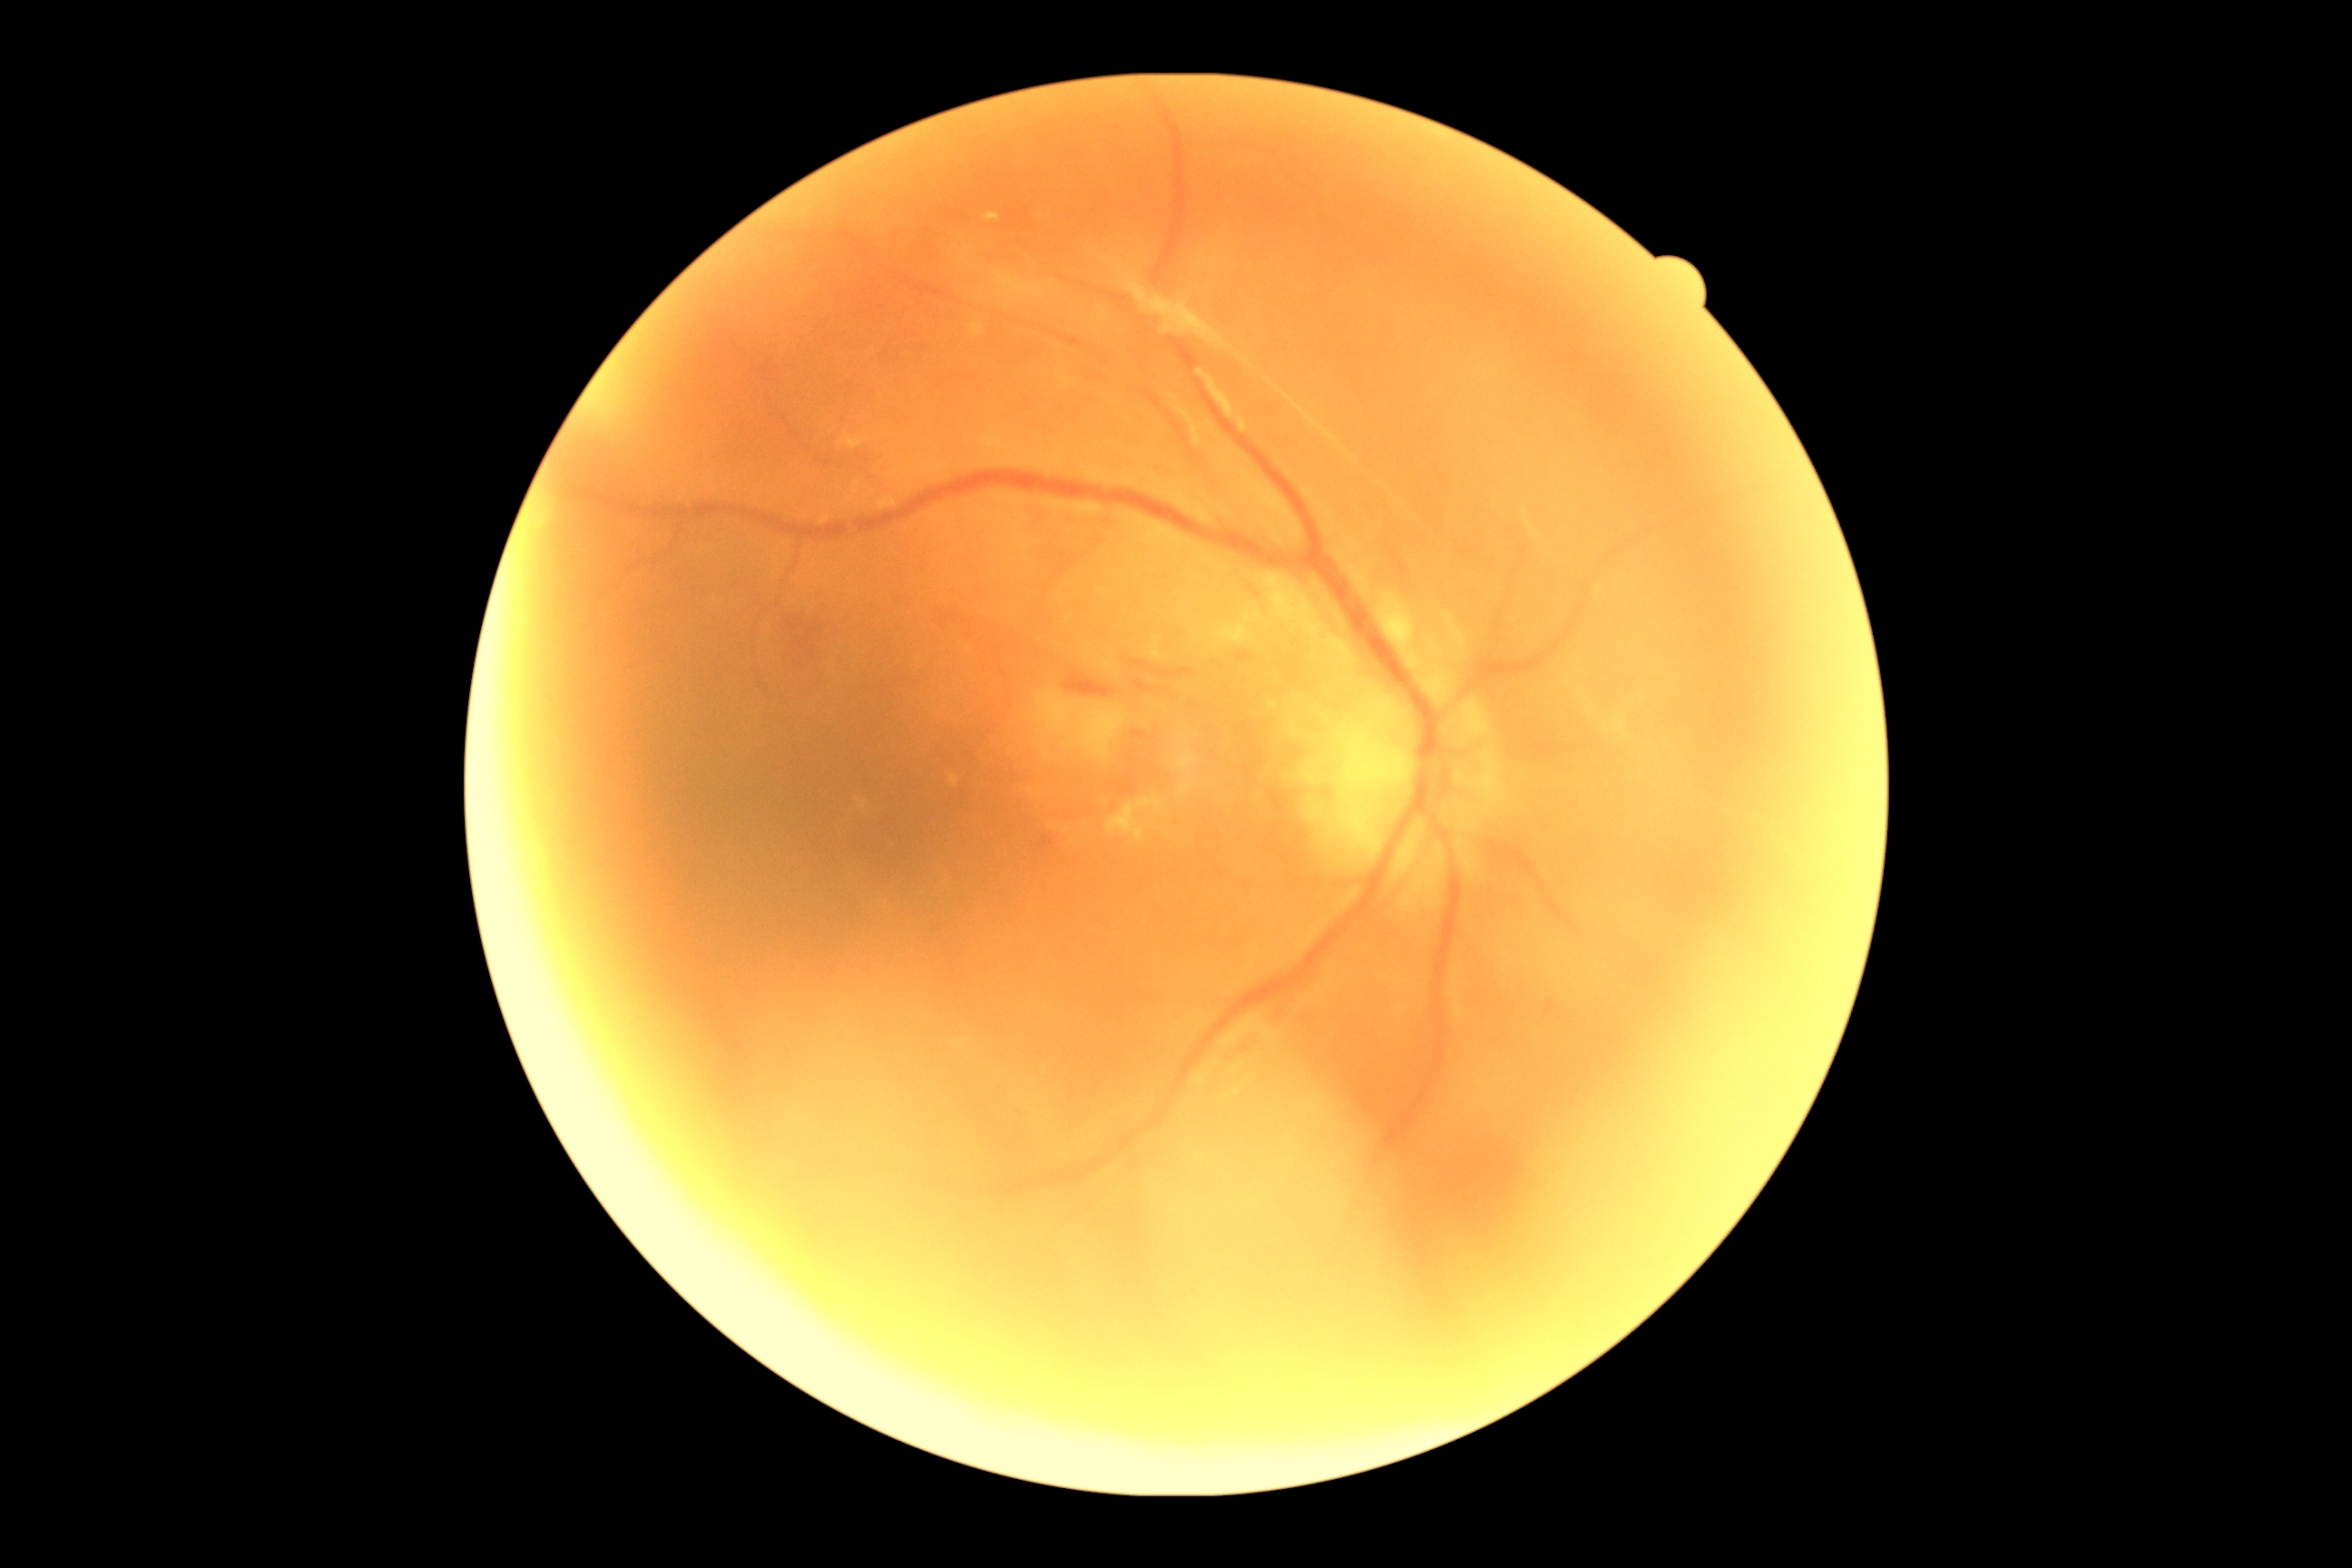 Findings:
– DR severity — grade 4